45° FOV: 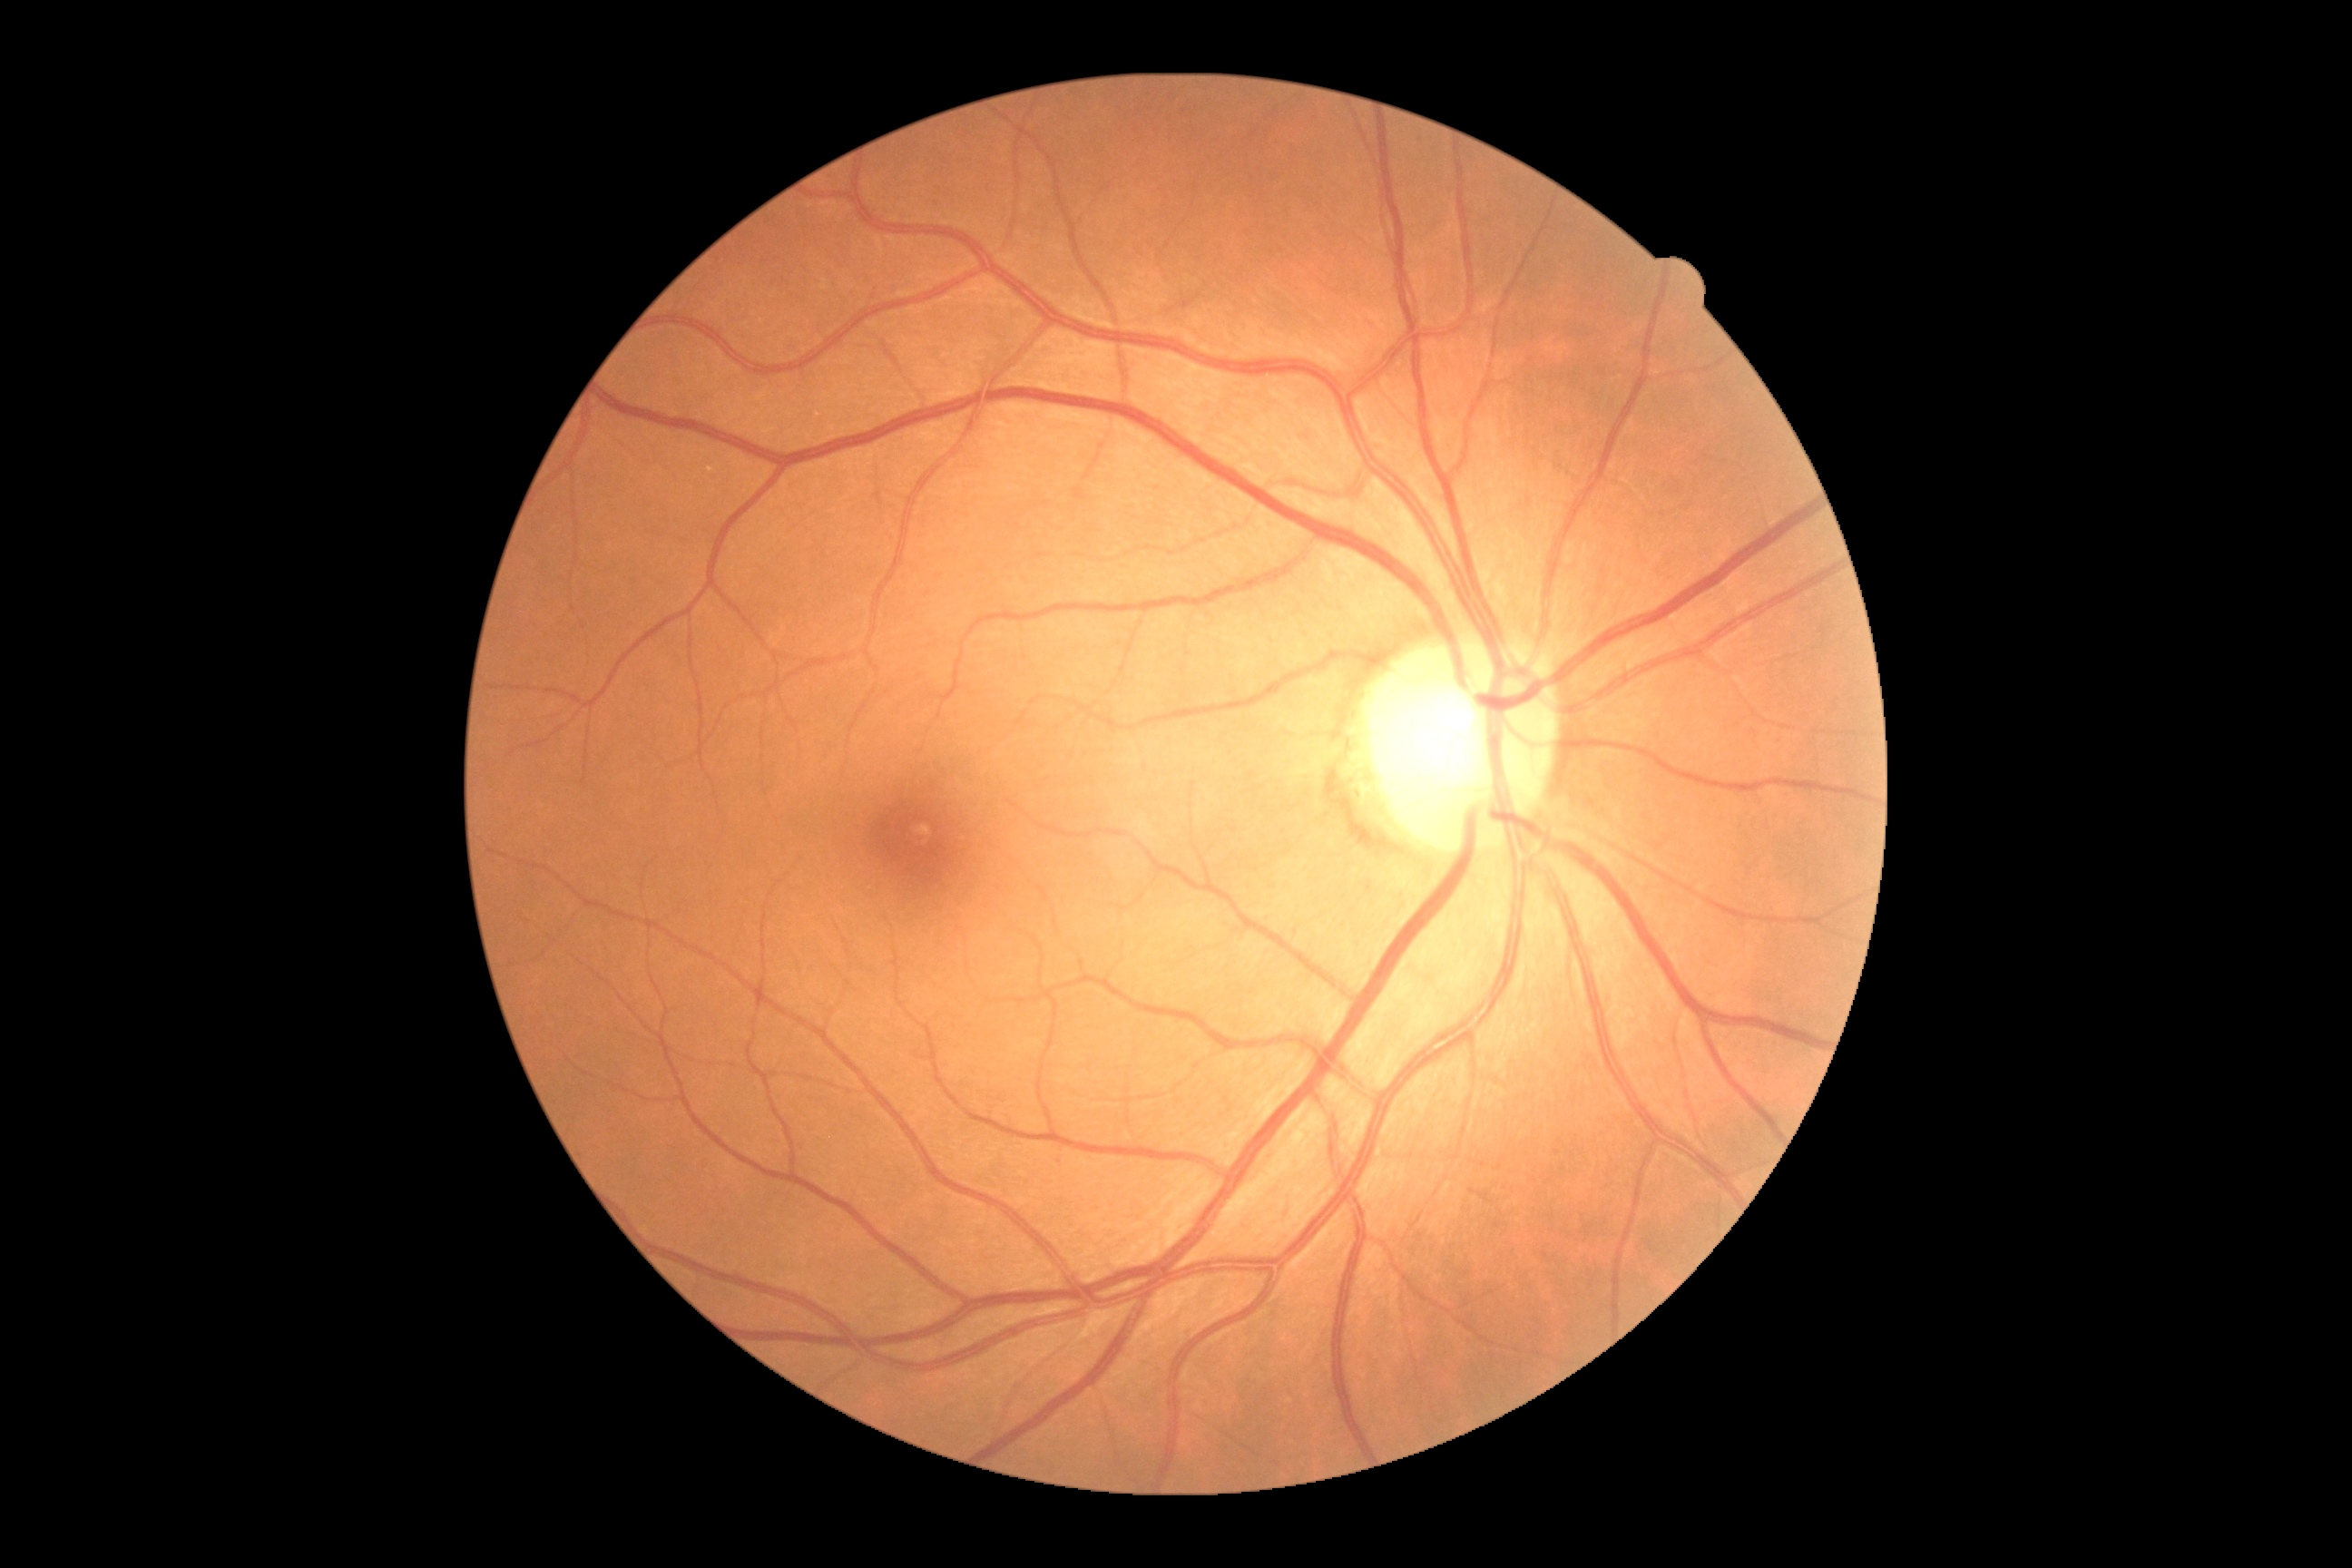
DR grade: no apparent retinopathy (0) — no visible signs of diabetic retinopathy | DR impression: no signs of DR.